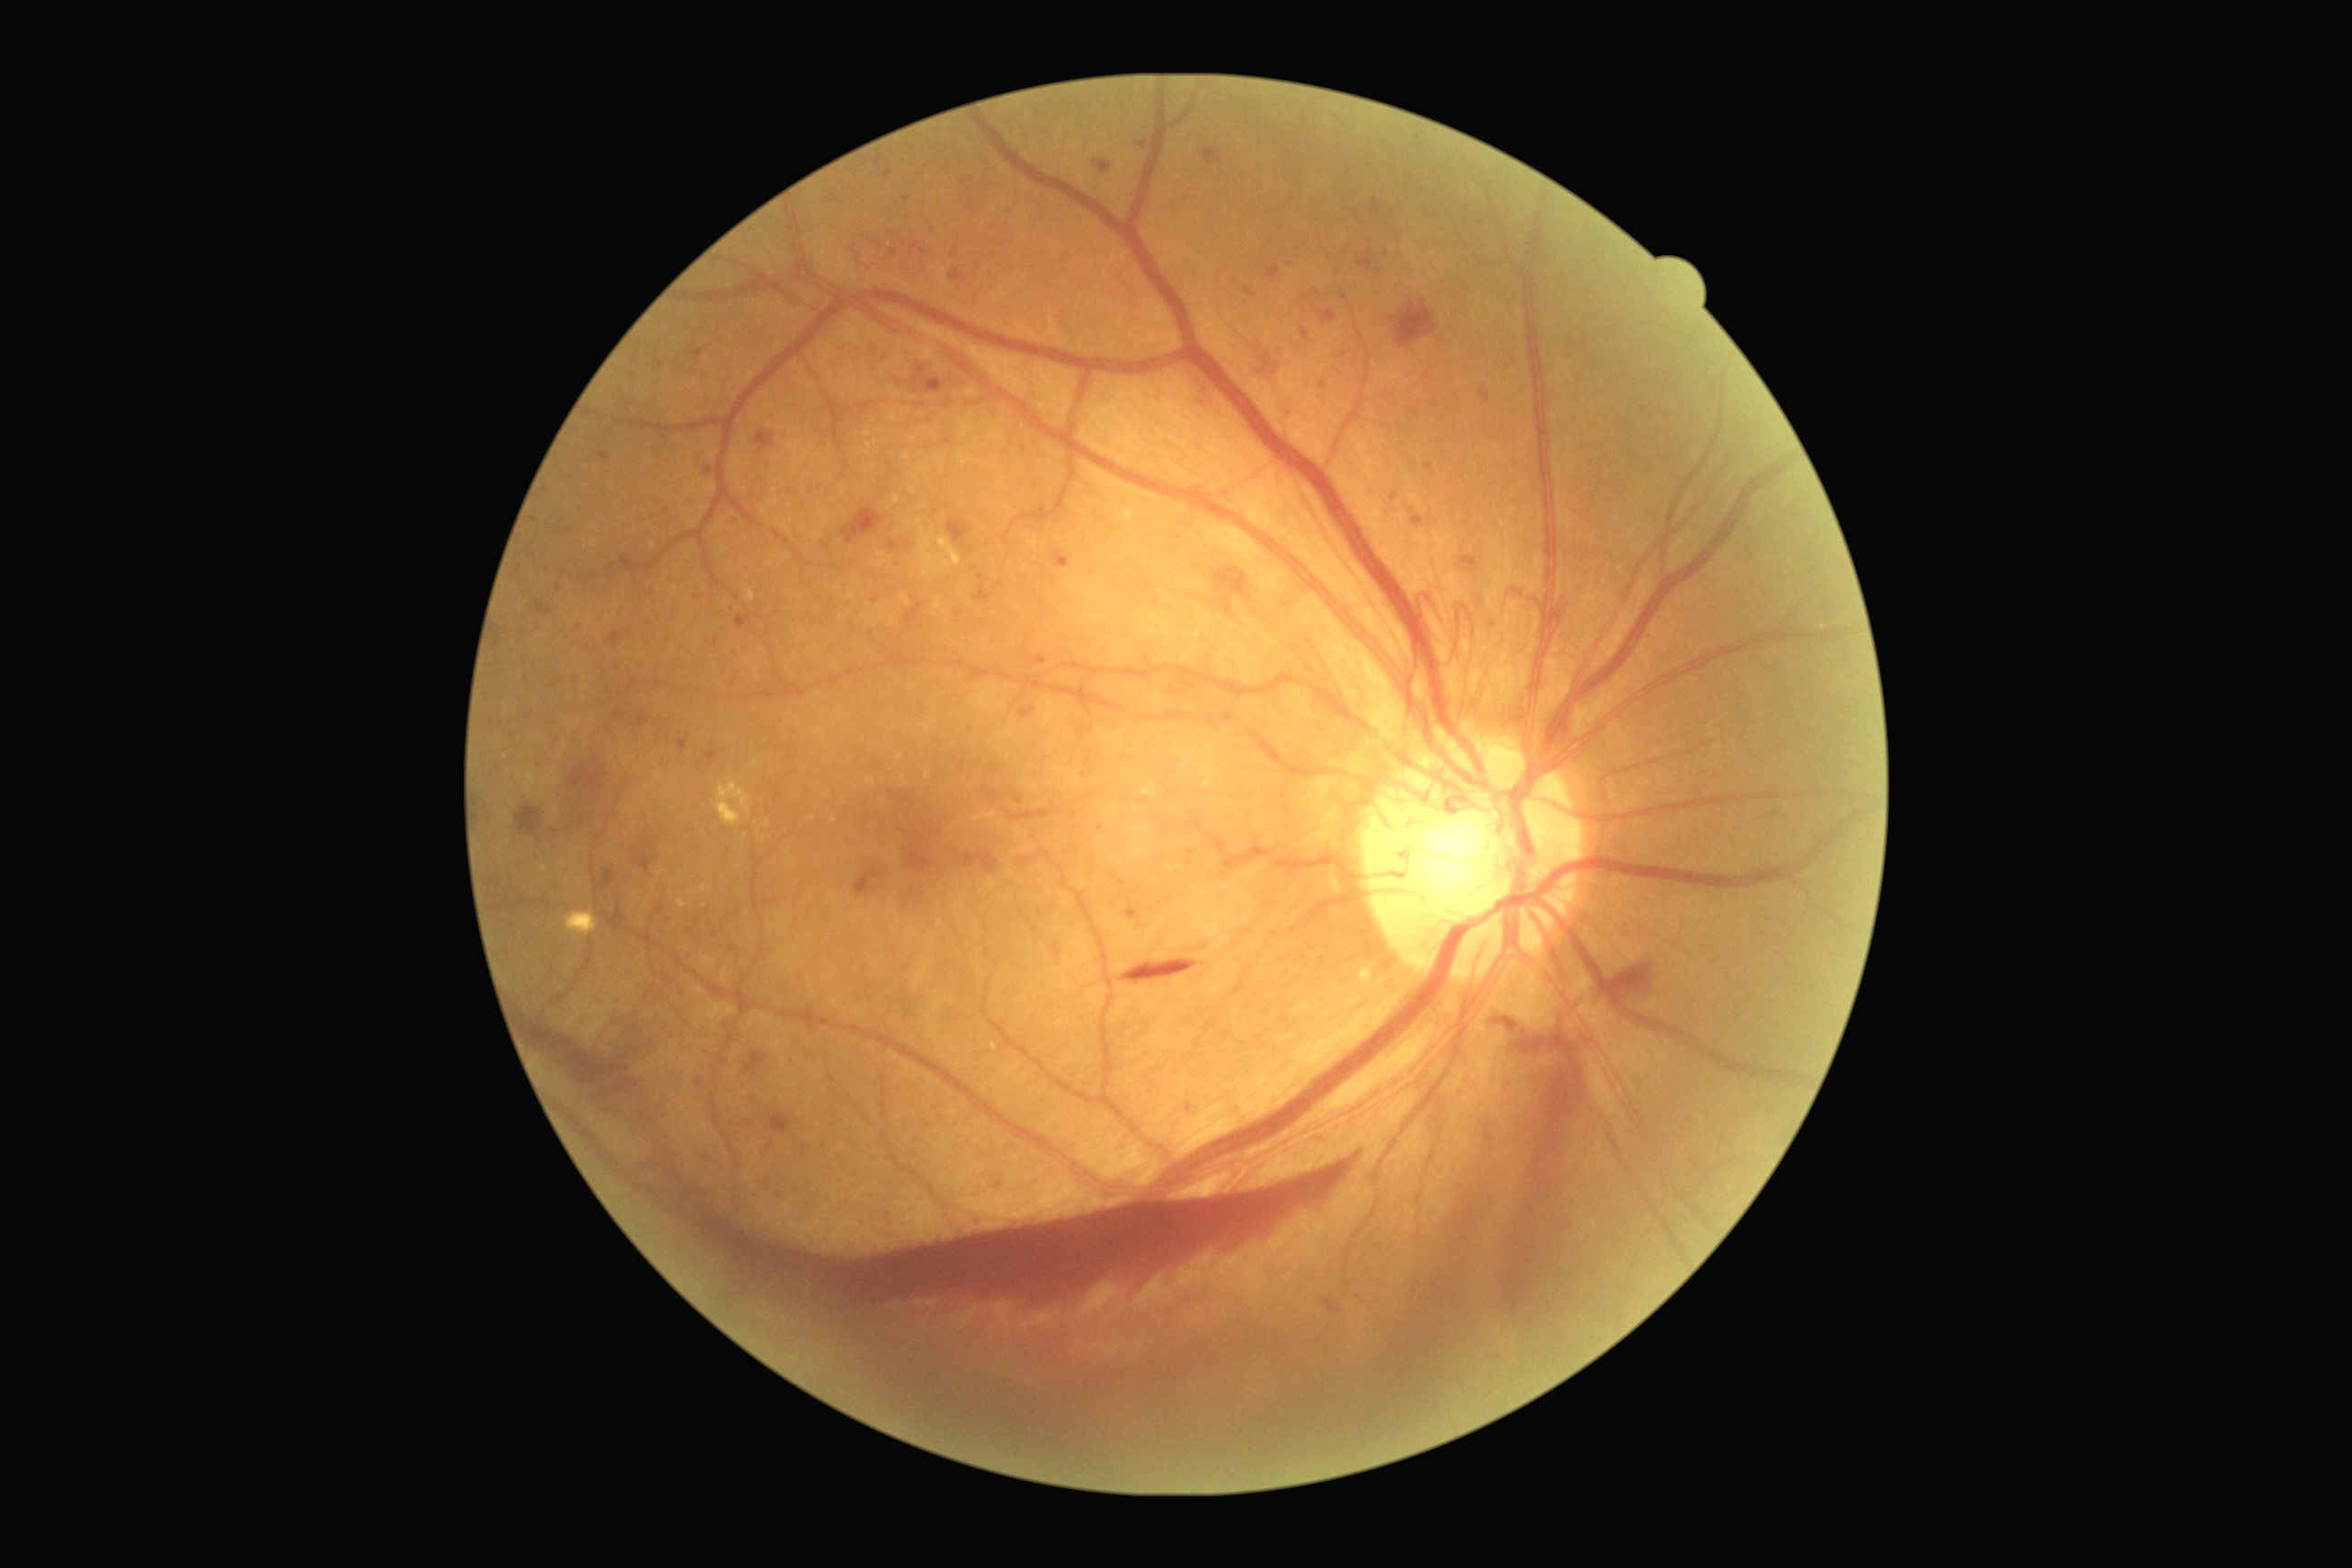

Diabetic retinopathy severity: 4; proliferative diabetic retinopathy
Lesions identified (partial list):
• microaneurysms (continued): <box>1019,707,1035,718</box>; <box>828,193,838,202</box>; <box>1244,288,1255,299</box>; <box>888,231,897,237</box>; <box>903,242,906,250</box>; <box>1188,1104,1193,1112</box>; <box>1411,516,1424,527</box>; <box>596,453,611,464</box>; <box>607,632,622,647</box>; <box>1260,351,1275,371</box>
• Smaller microaneurysms around 550, 726; 554, 831; 877, 242; 1190, 863; 895, 253; 906, 199